1920 x 1440 pixels. CFP
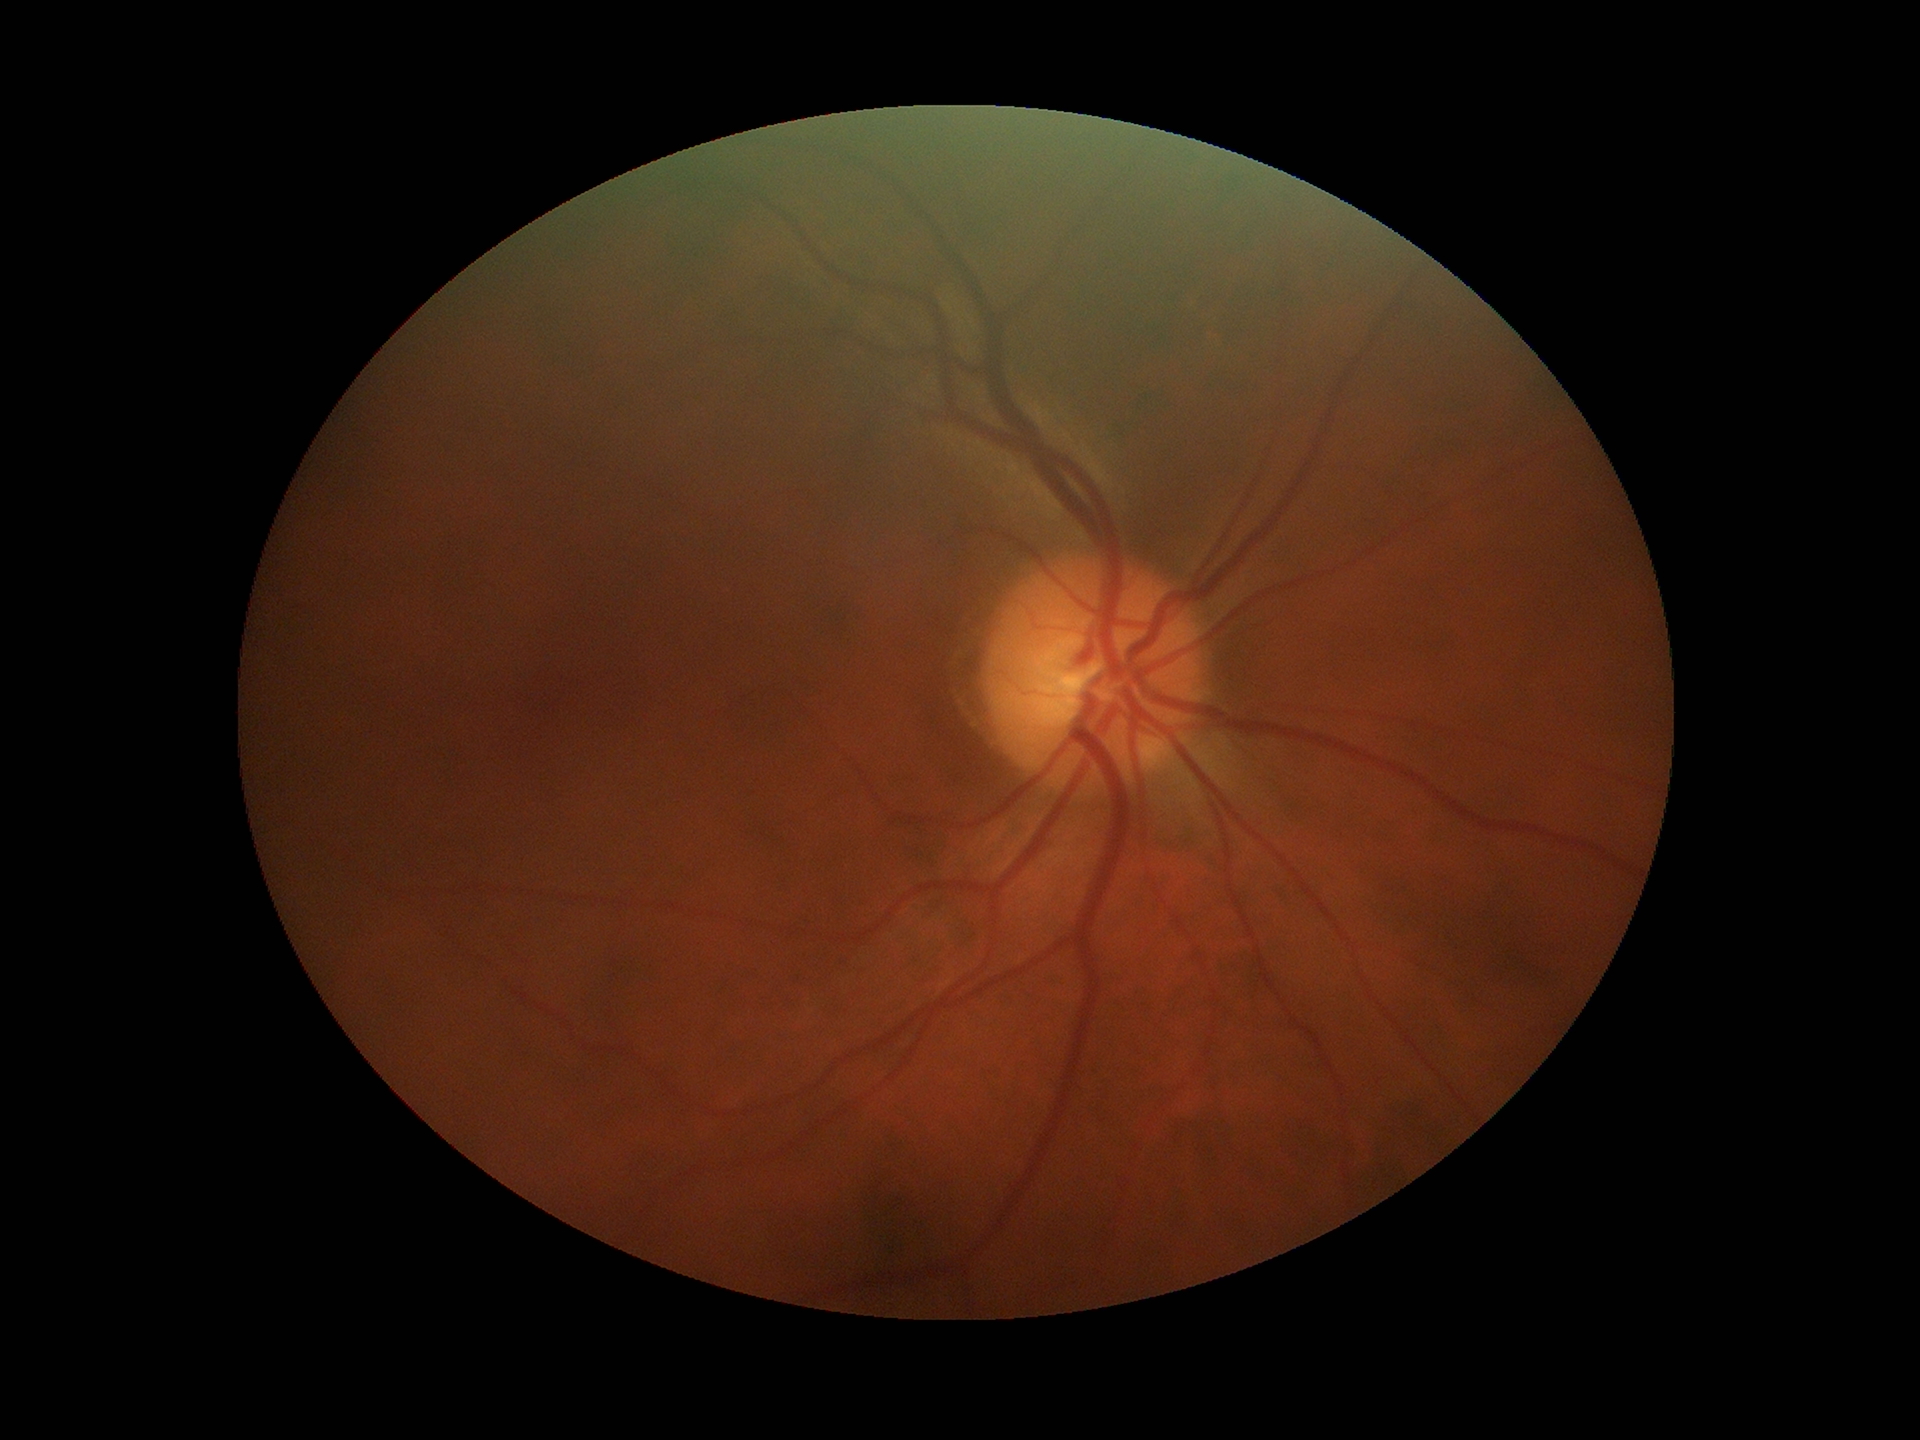

Glaucoma impression: not suspect; horizontal cup-to-disc ratio (HCDR): 0.48; vertical CDR (VCDR): 0.53.